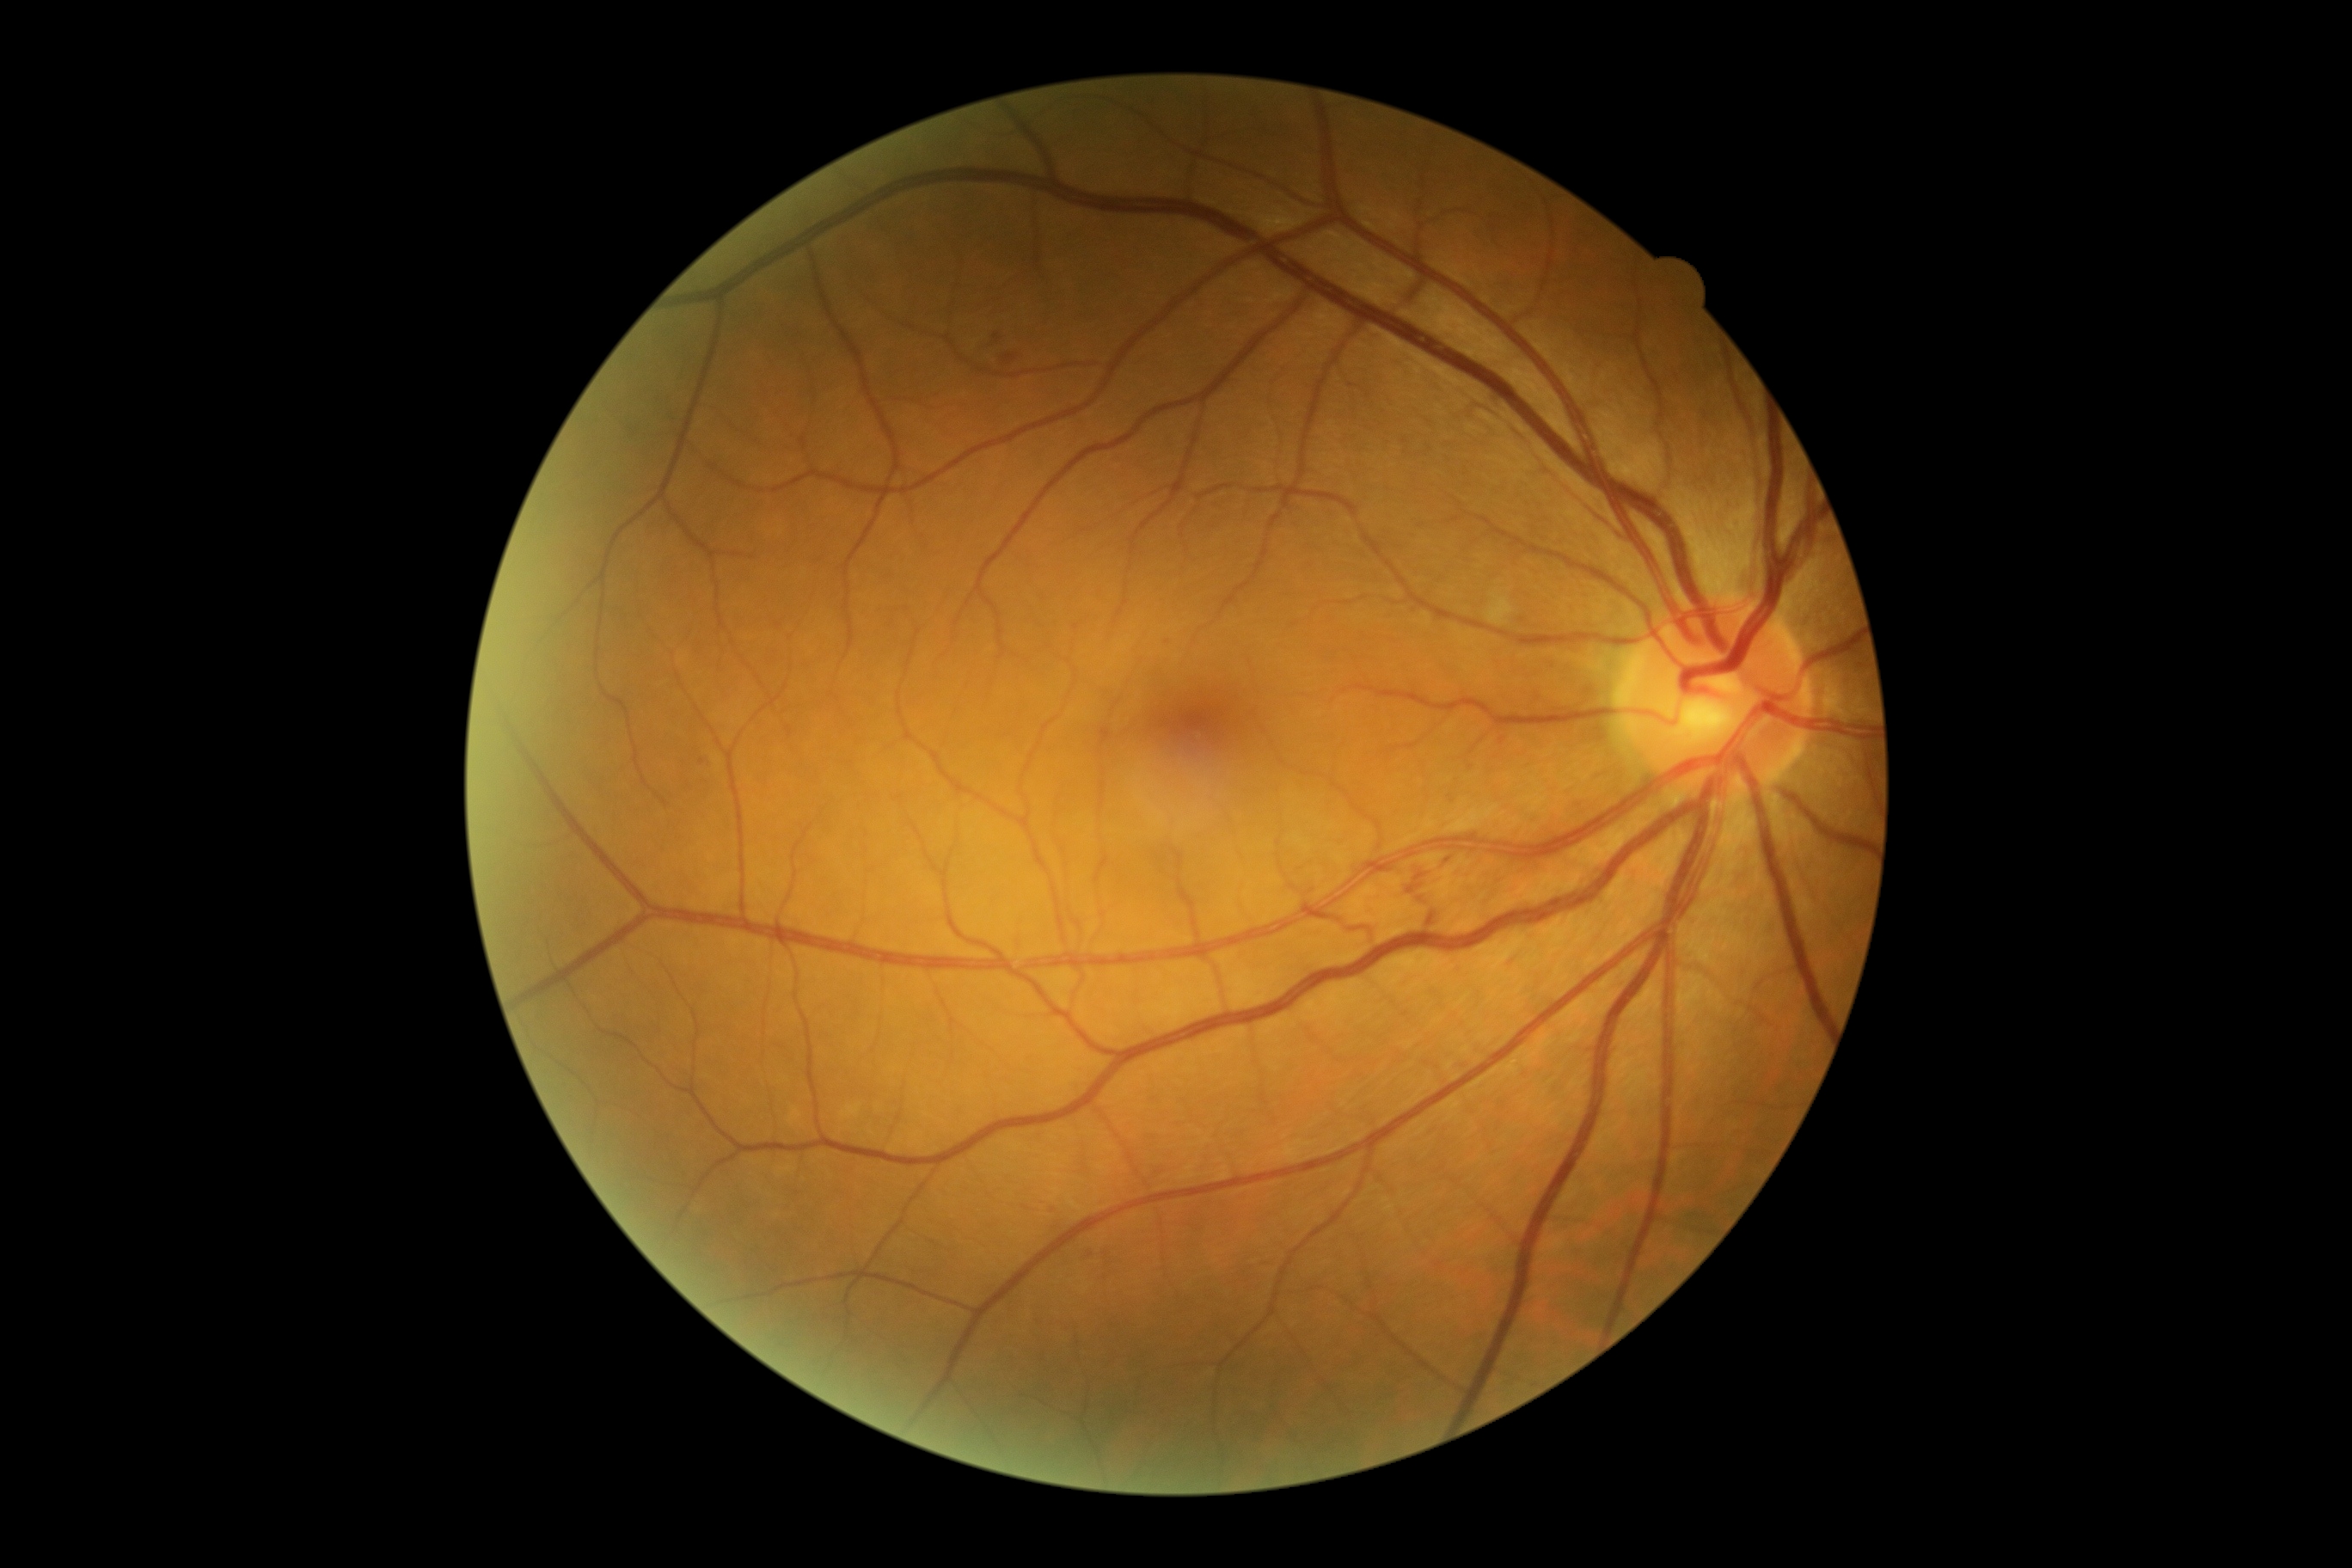

DR grade is 2 — more than just microaneurysms but less than severe NPDR; non-proliferative diabetic retinopathy
EXs: absent
HEs: box=[1003, 355, 1017, 364]
Small HEs approximately at (x=997, y=337)
Small MAs approximately at (x=1167, y=641); (x=702, y=762)
SEs: absent